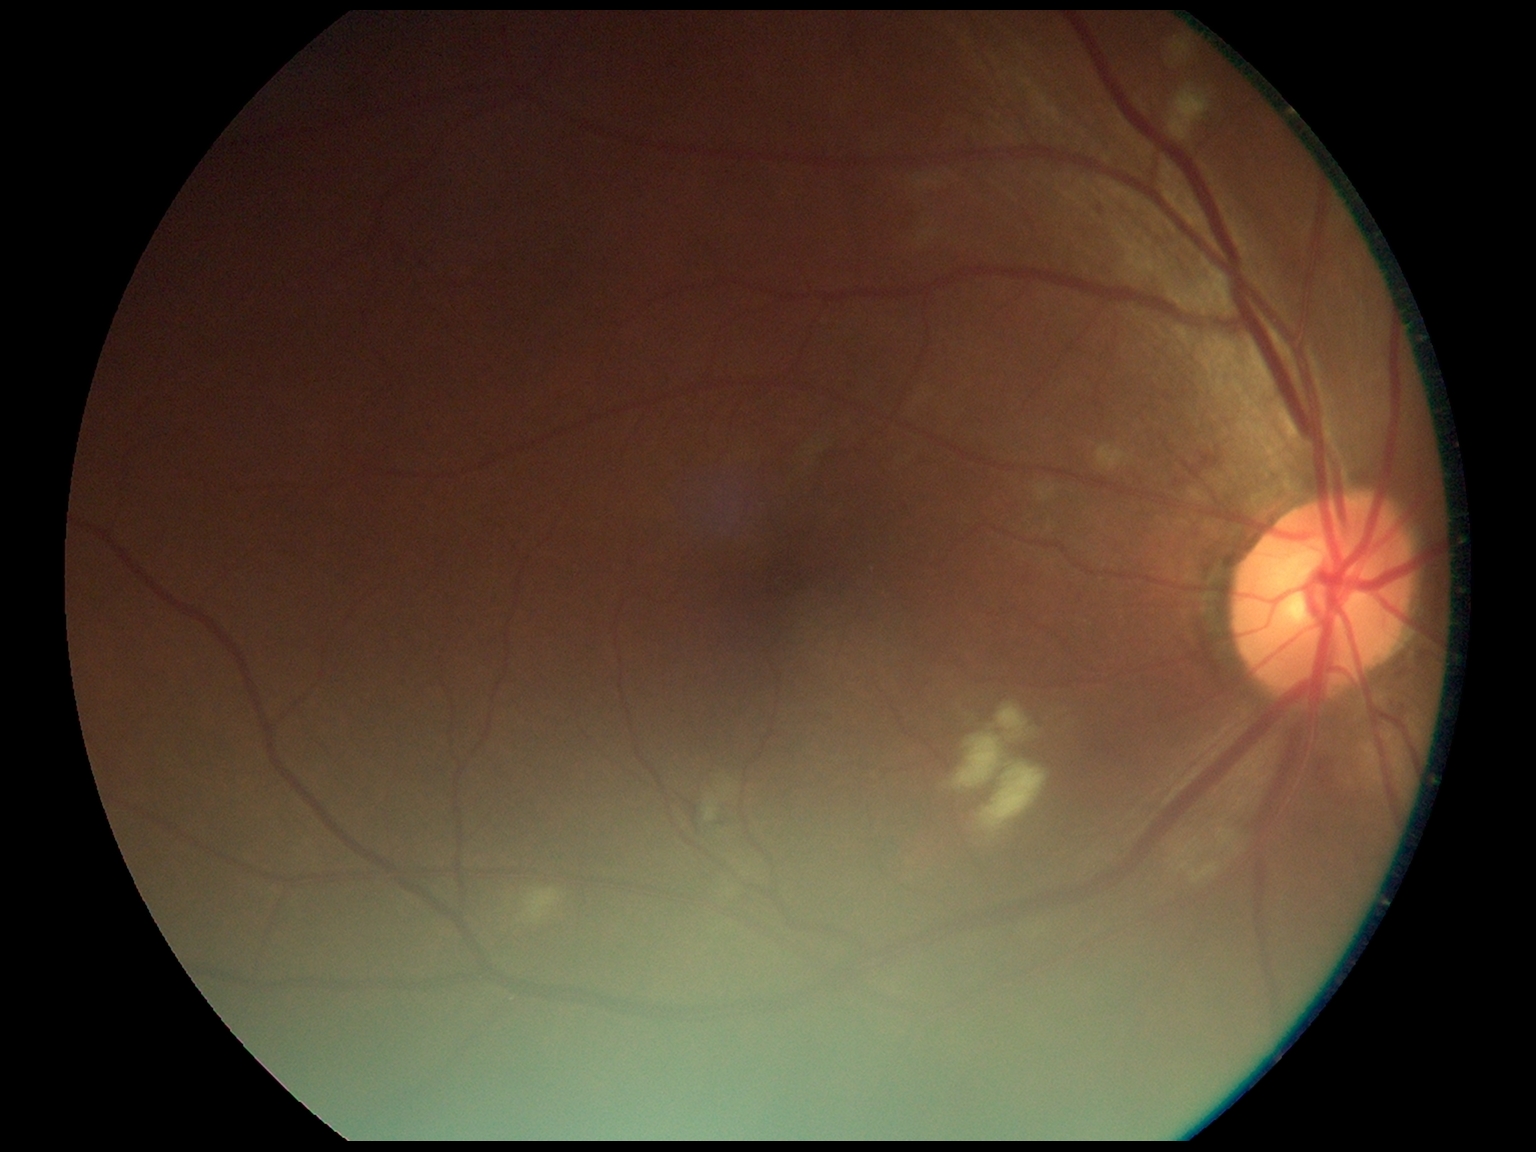

Diabetic retinopathy is grade 2 (moderate NPDR).
The retinopathy is classified as non-proliferative diabetic retinopathy.